NIDEK AFC-230 fundus camera · 45-degree field of view · nonmydriatic · 848 by 848 pixels · posterior pole photograph: 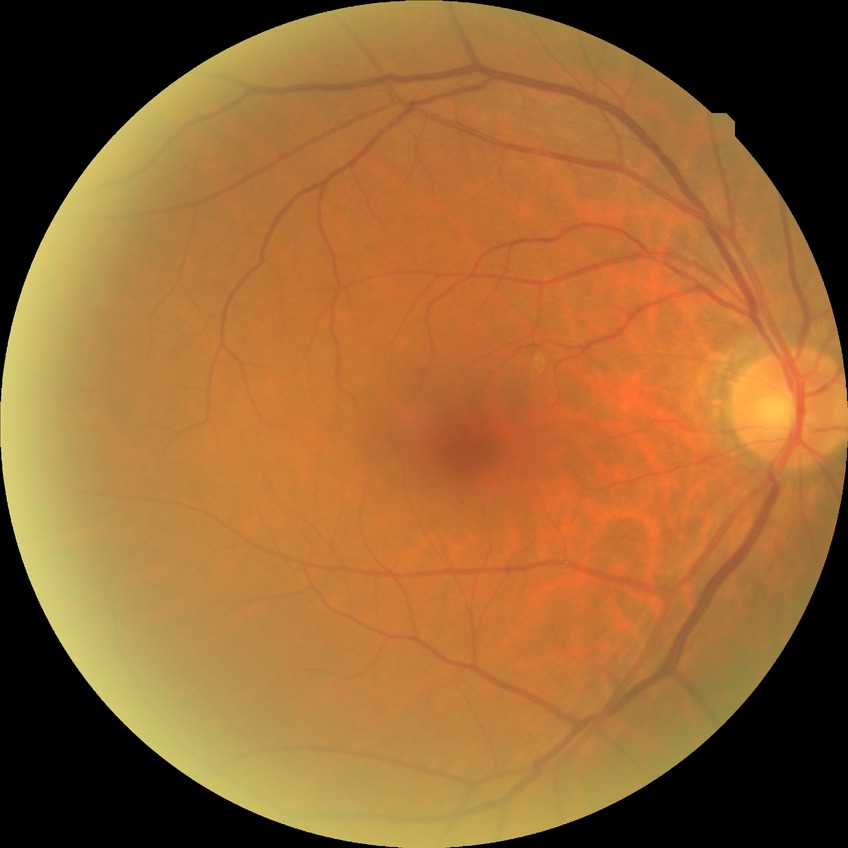

Diabetic retinopathy (DR) is no diabetic retinopathy (NDR).